45-degree field of view, color fundus photograph, image size 2352x1568:
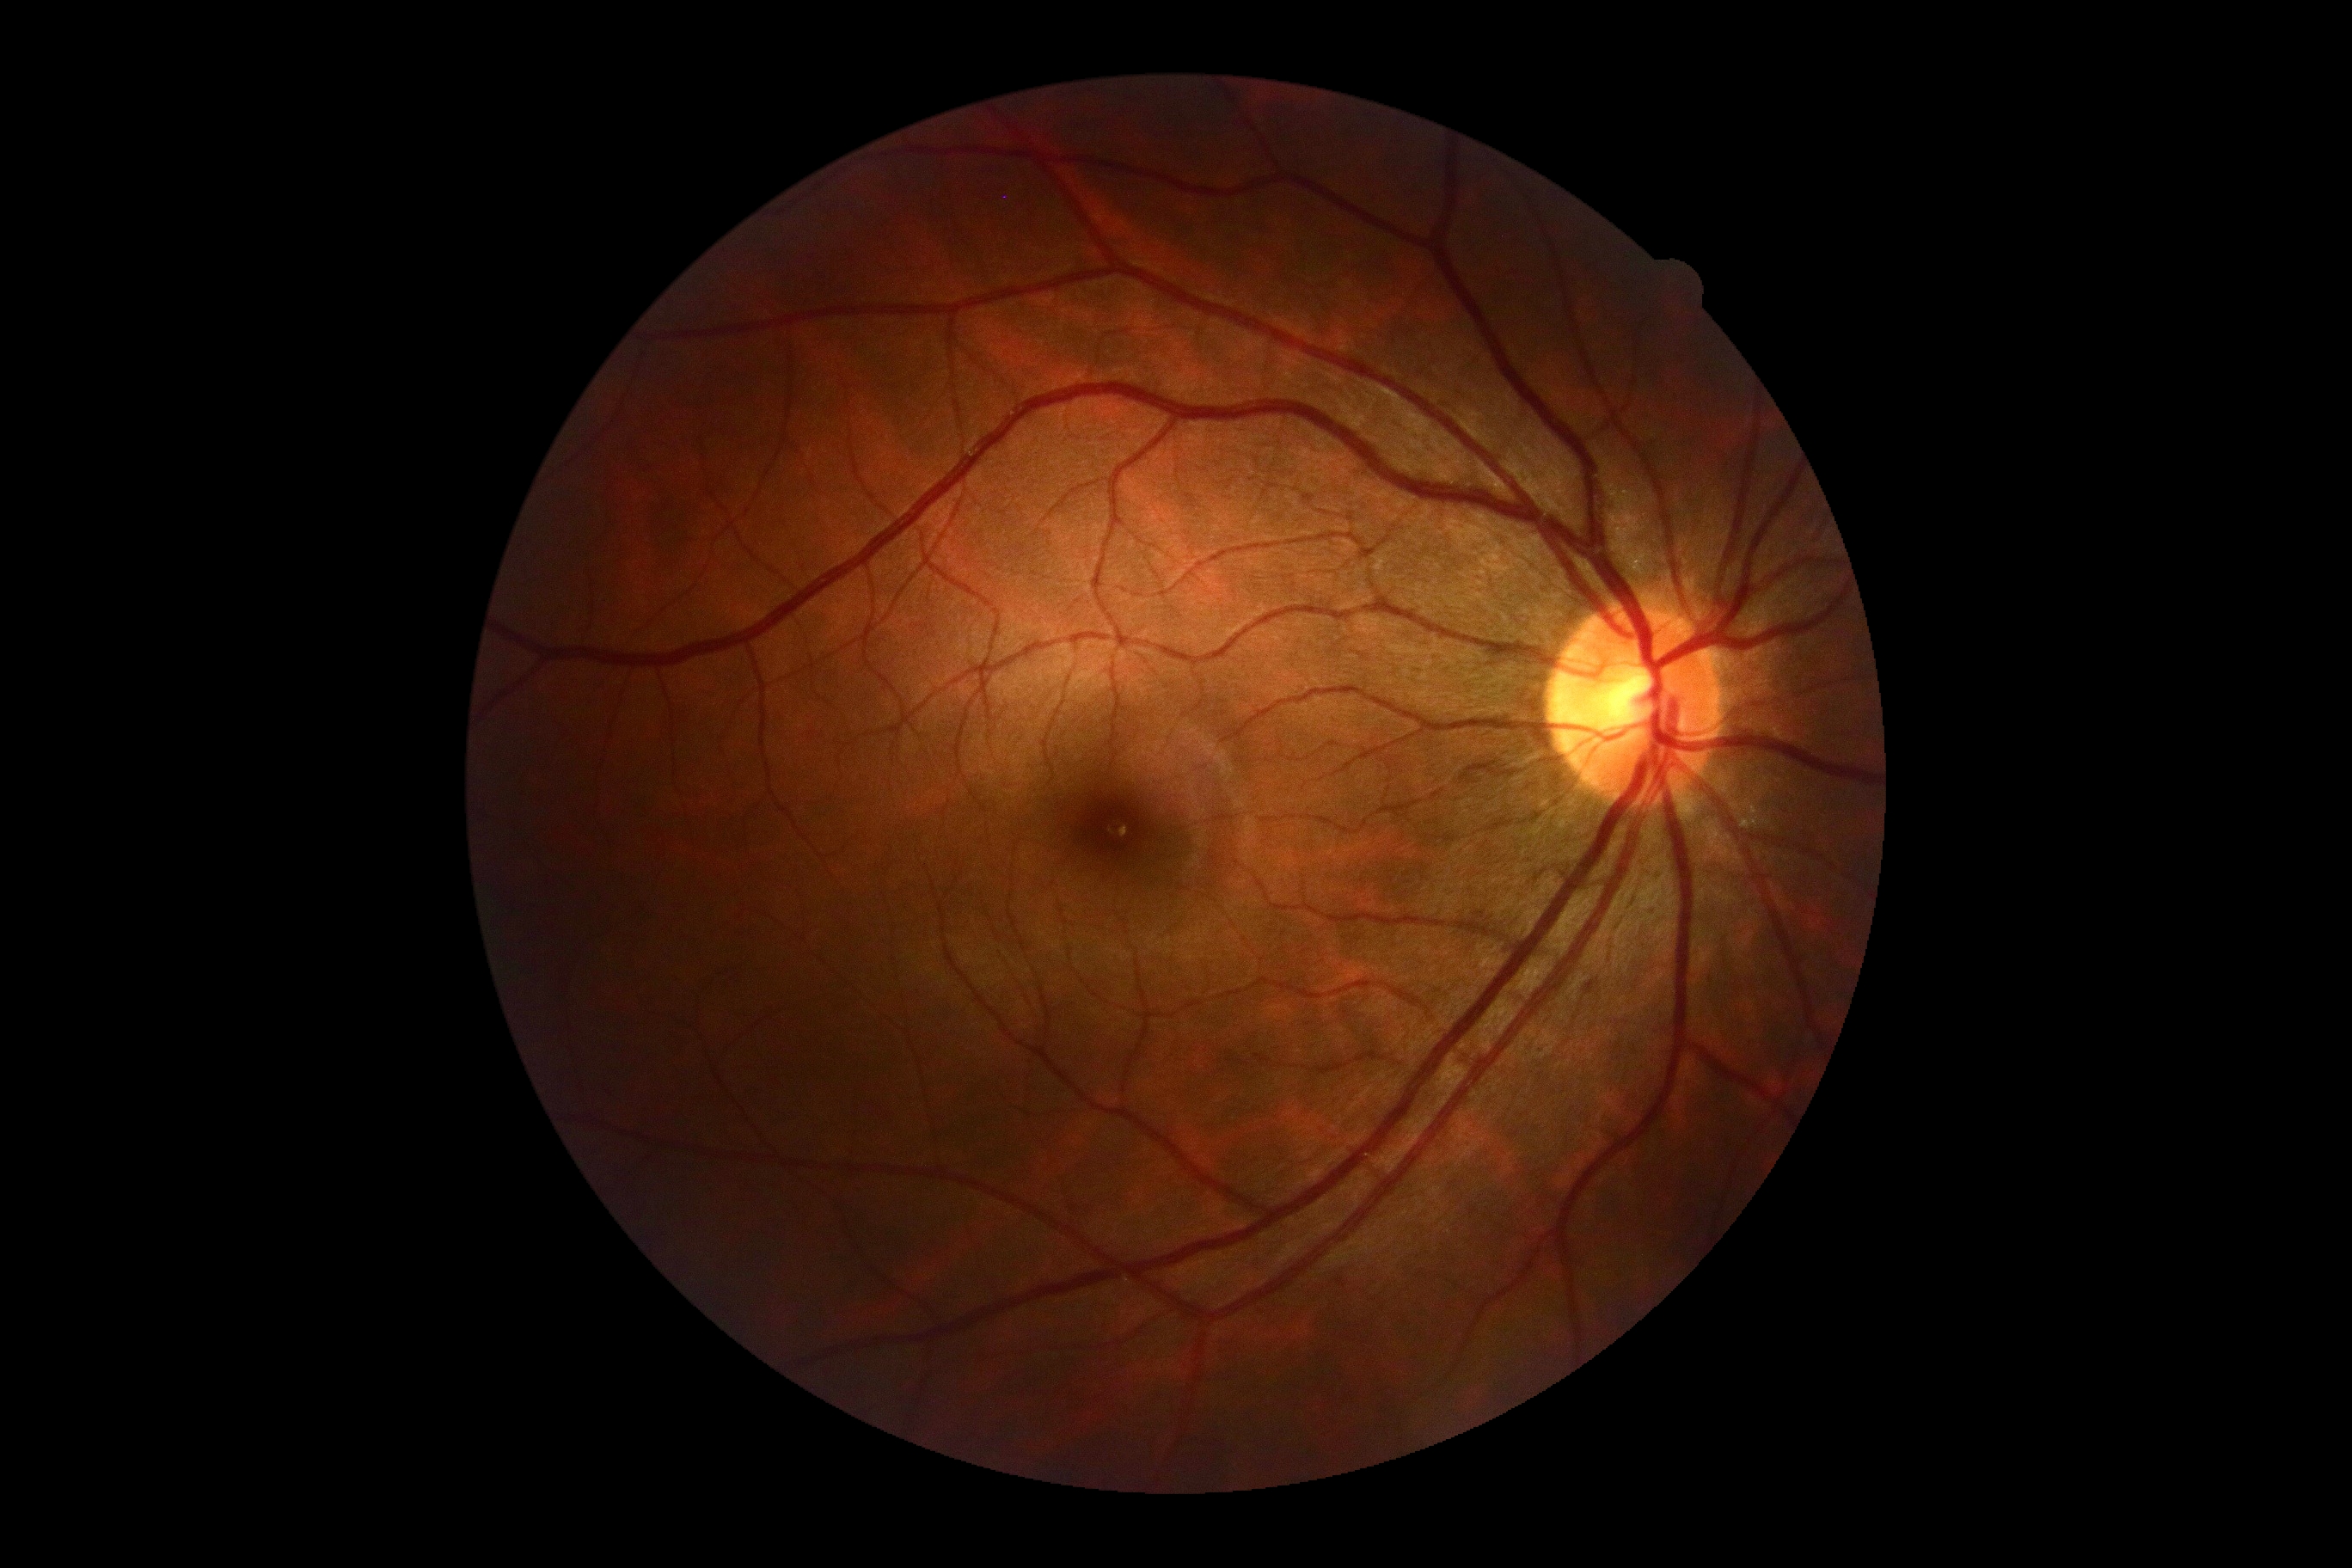
Diabetic retinopathy severity: no apparent diabetic retinopathy (grade 0).